848 by 848 pixels; color fundus image: 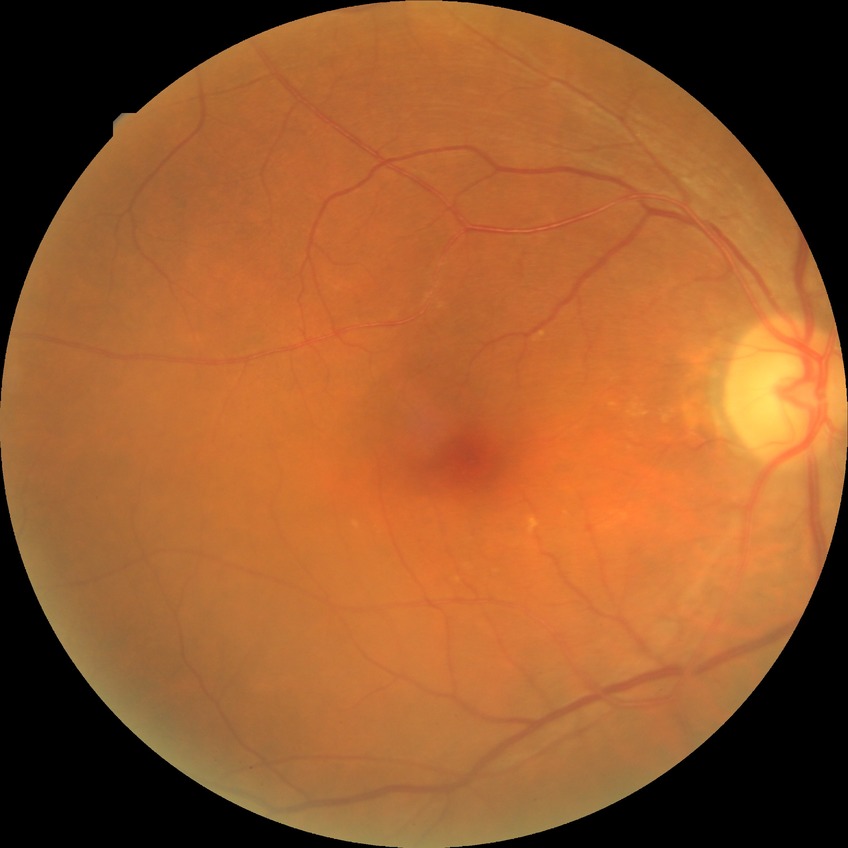 Modified Davis classification: no diabetic retinopathy.